848x848; camera: NIDEK AFC-230; without pupil dilation:
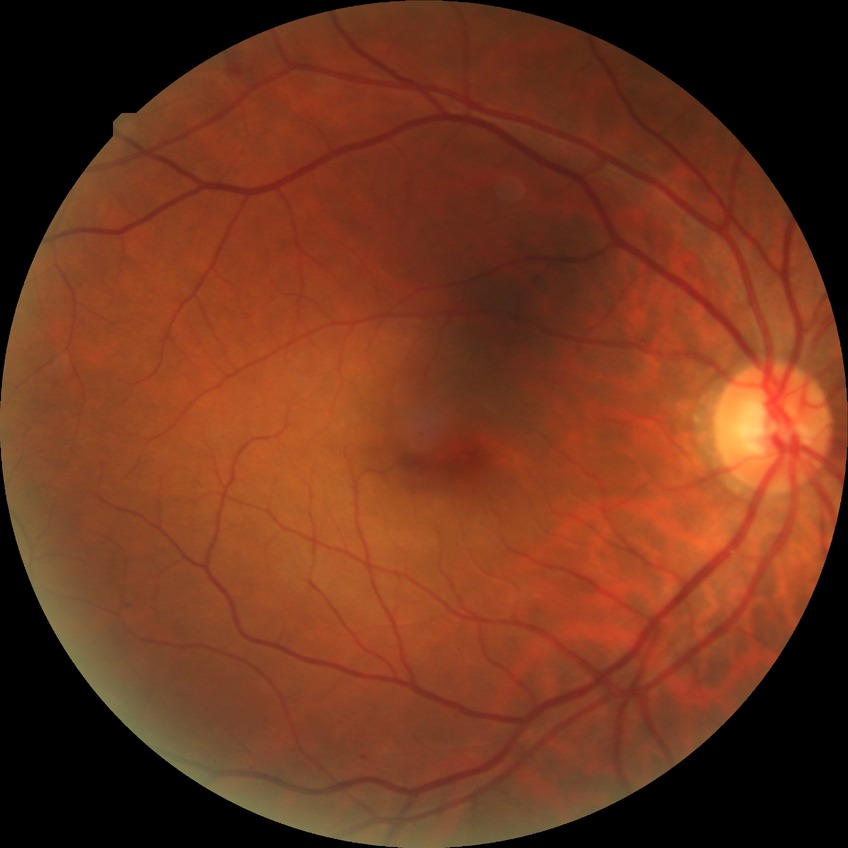
- diabetic retinopathy (DR) — simple diabetic retinopathy (SDR)